Modified Davis grading. NIDEK AFC-230.
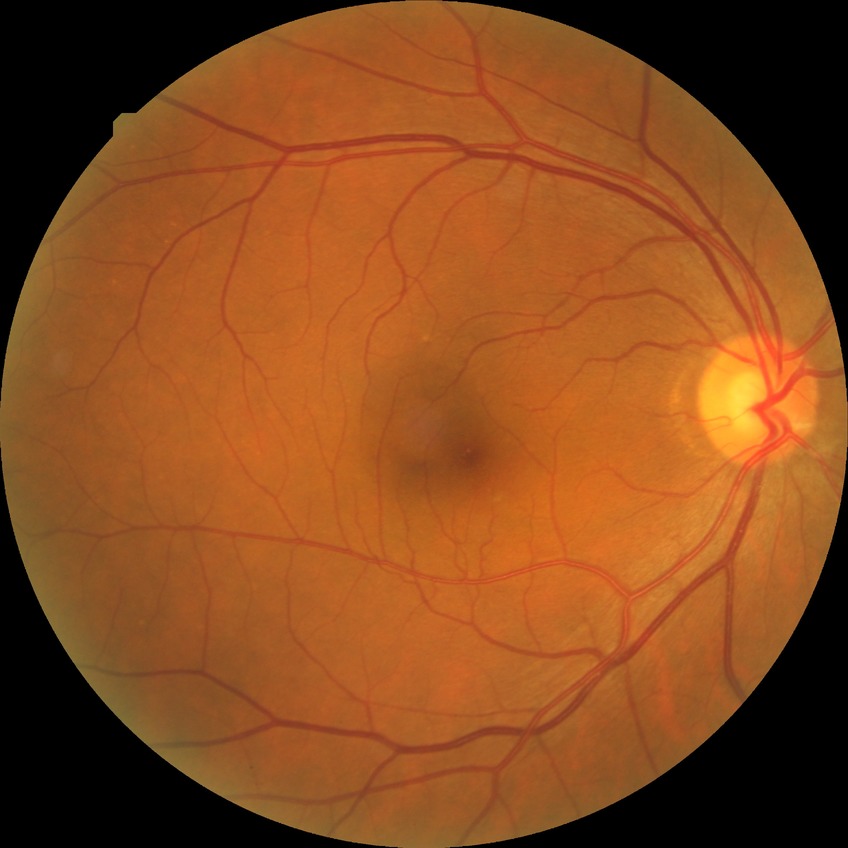

Diabetic retinopathy severity is no diabetic retinopathy.